Wide-field contact fundus photograph of an infant; acquired on the Clarity RetCam 3 — 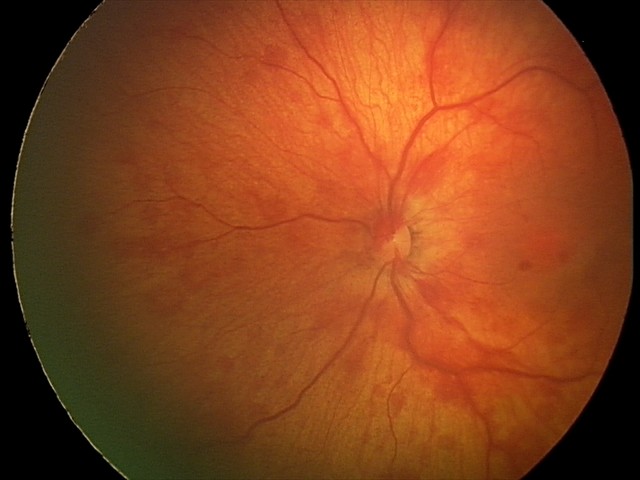
Series diagnosed as retinal hemorrhages.